45-degree field of view, nonmydriatic
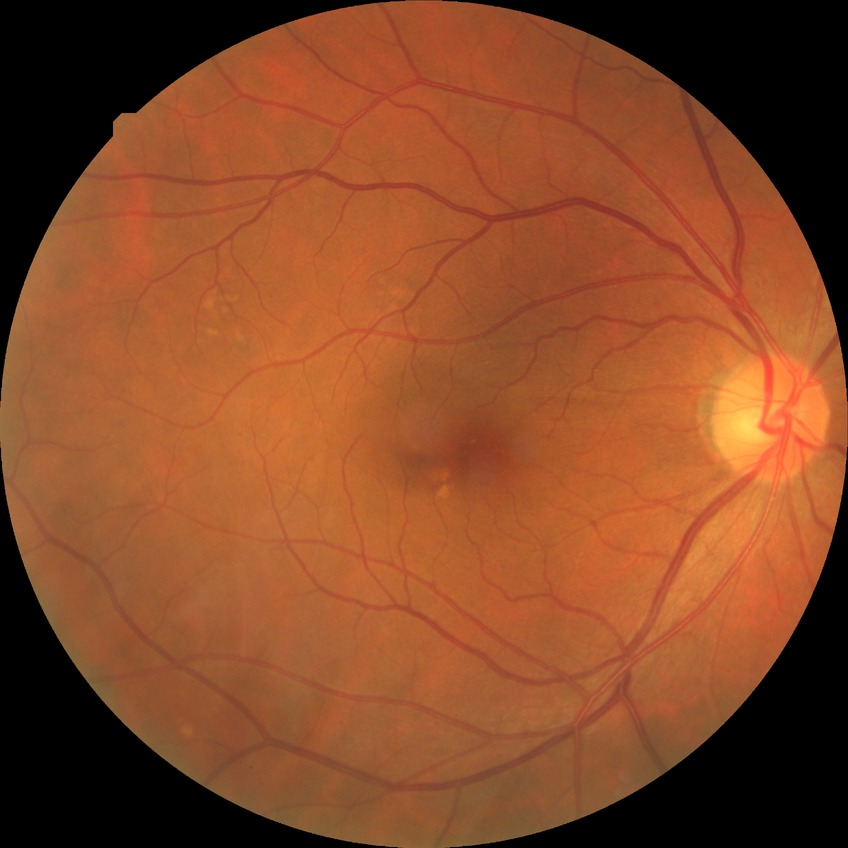
DR impression: no signs of DR; DR: NDR.